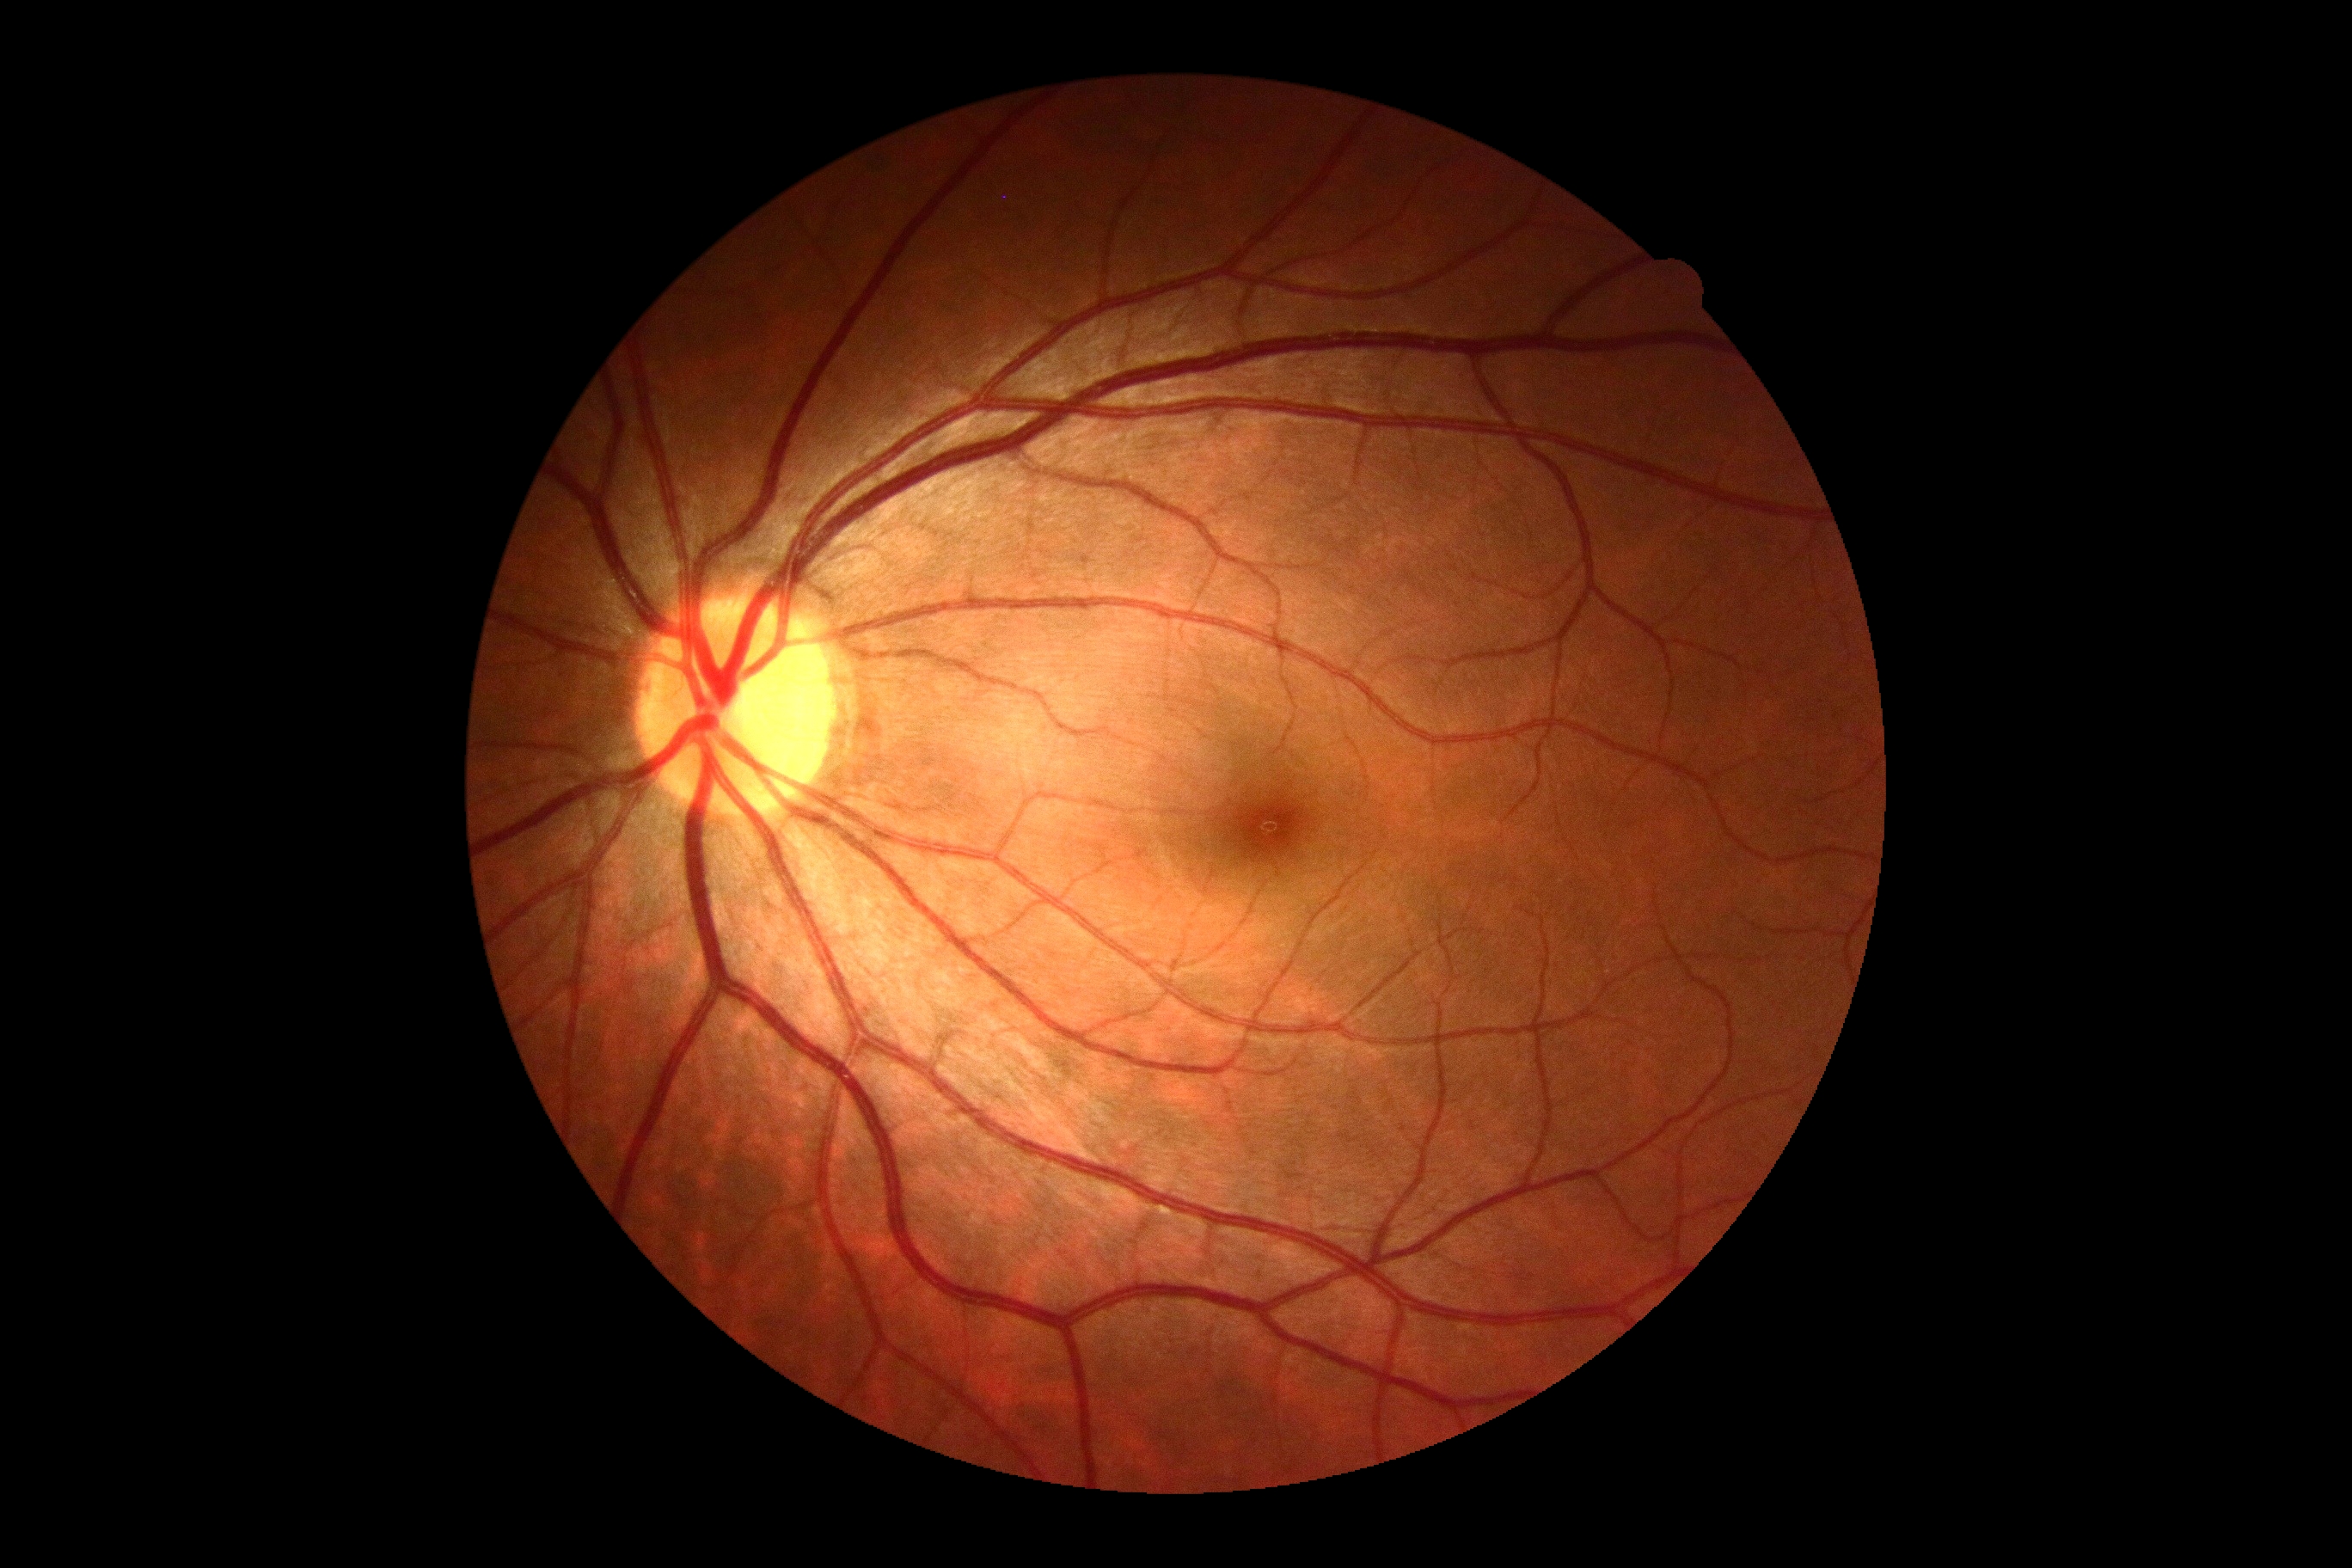 DR=0/4 — no visible signs of diabetic retinopathy.